CFP — 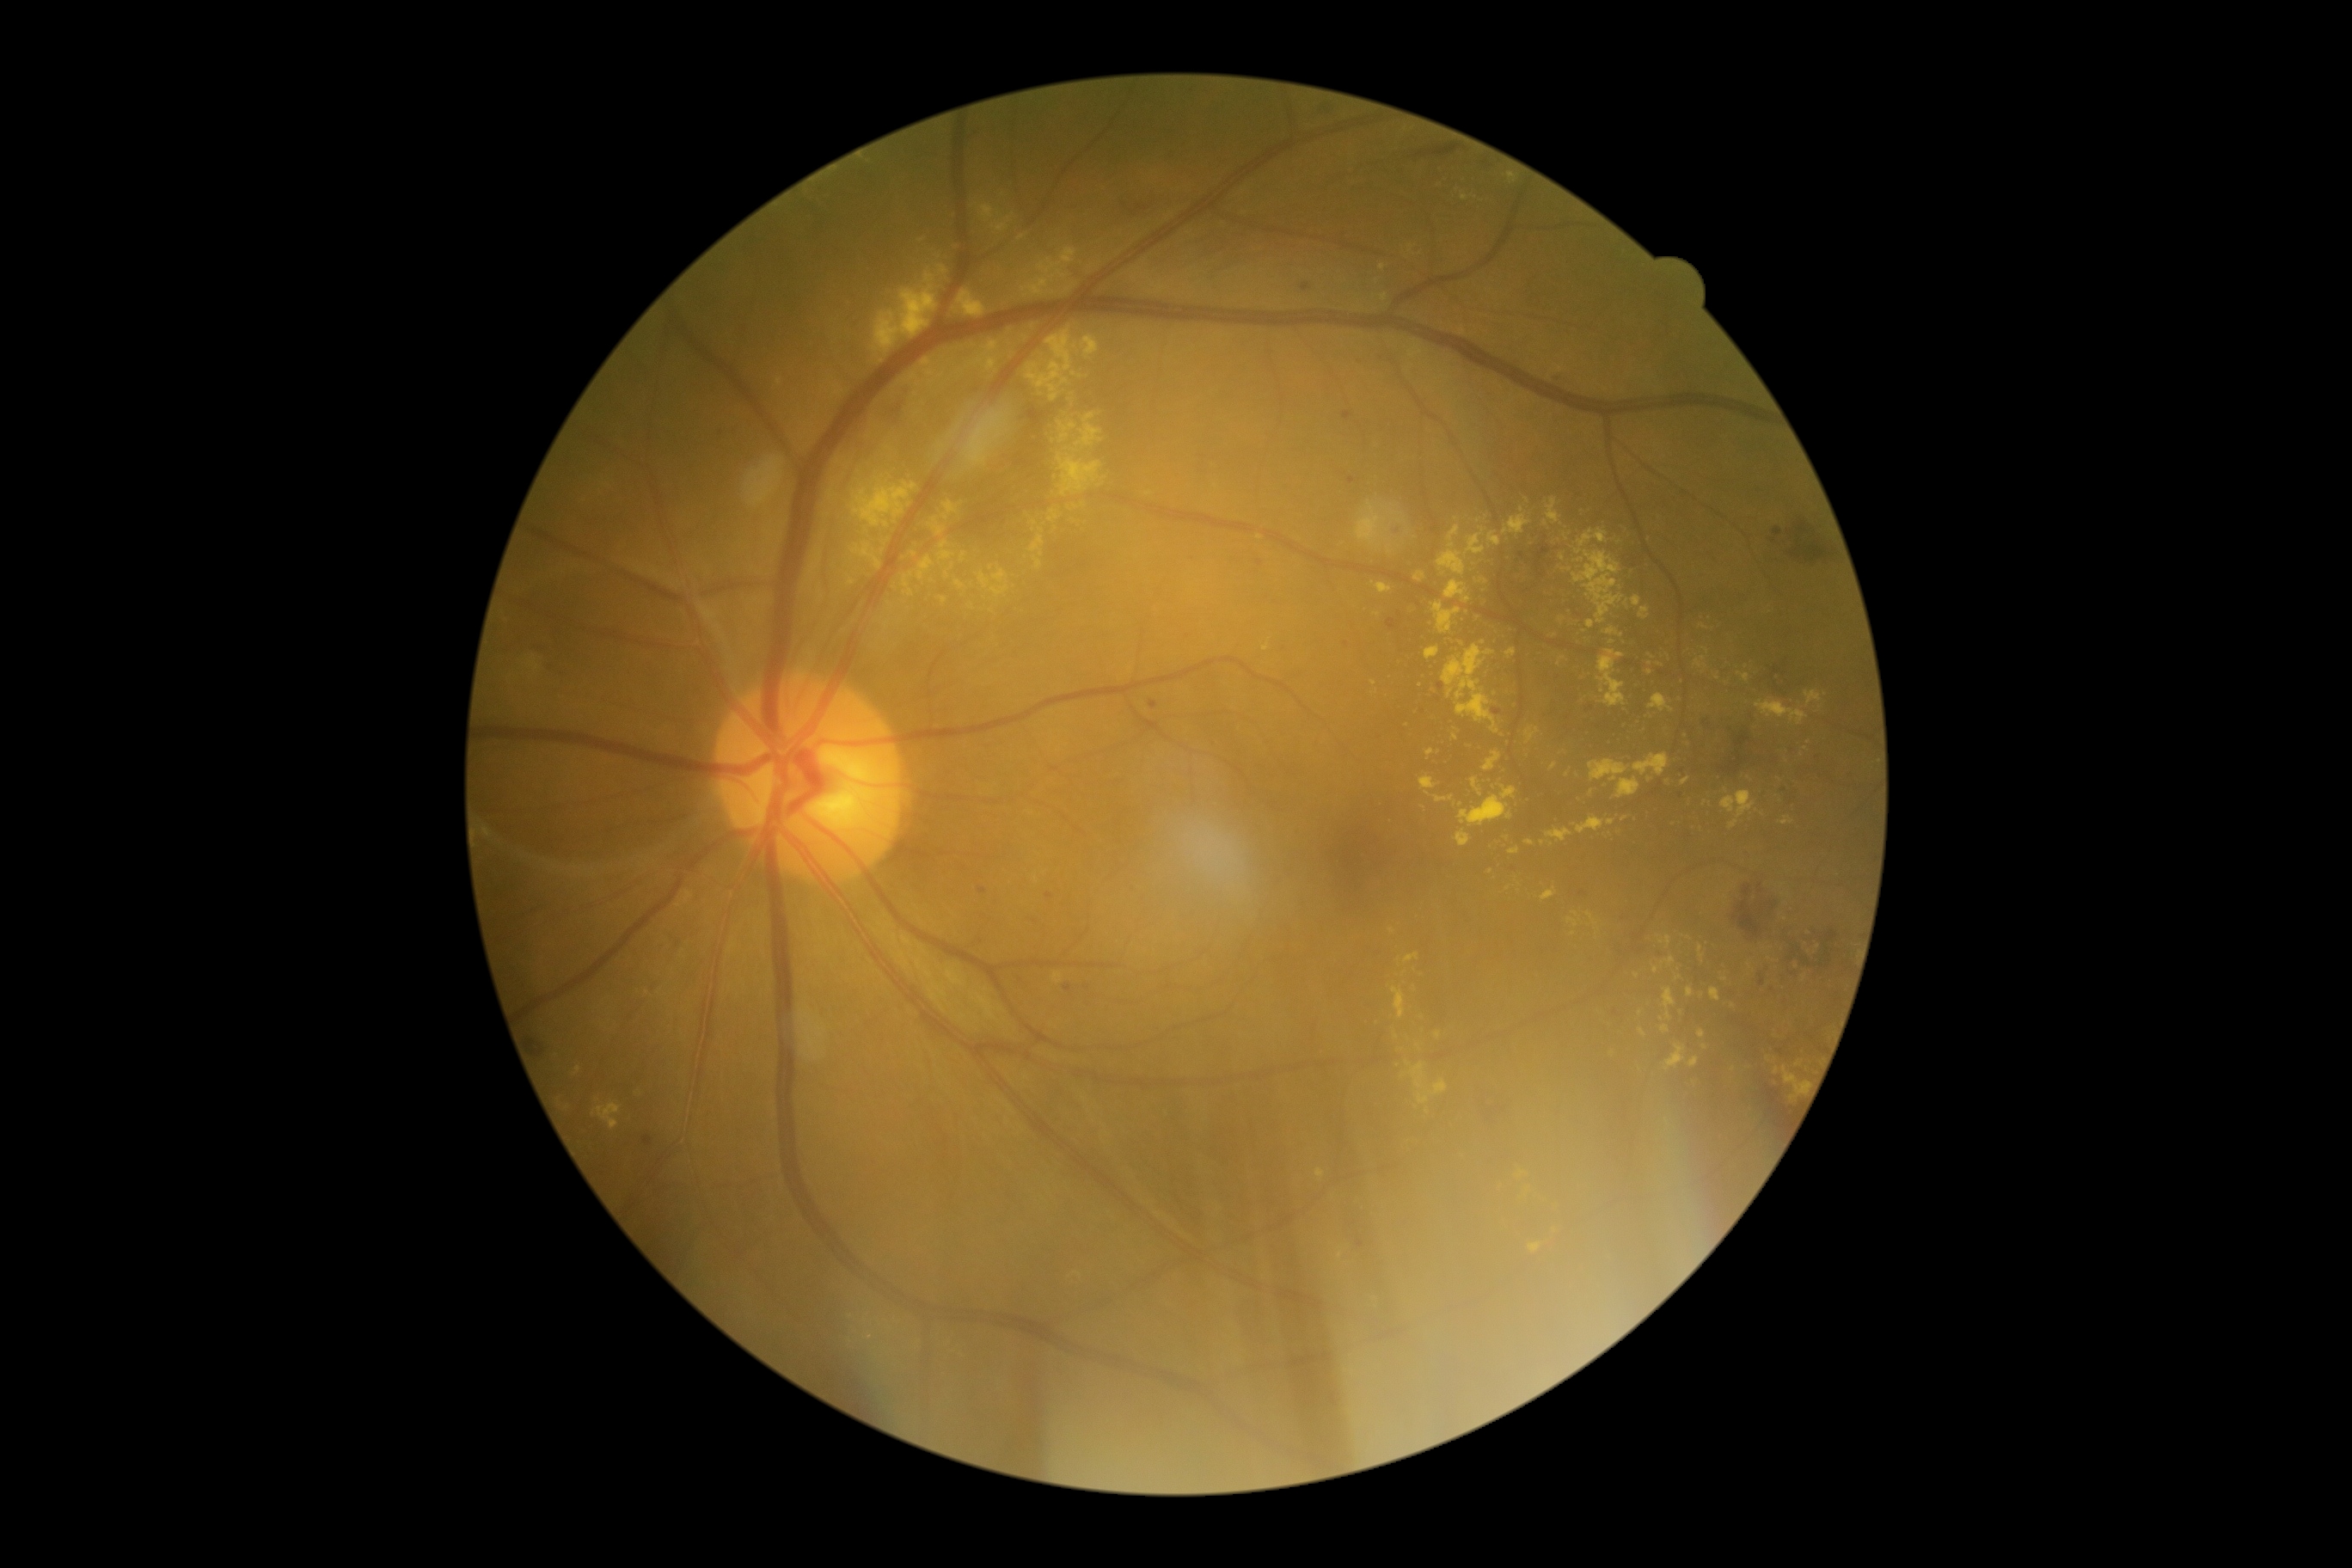 Retinopathy grade is moderate non-proliferative diabetic retinopathy (2) — more than just microaneurysms but less than severe NPDR
Representative lesions:
• hard exudates (subset): [850,542,883,570], [1067,448,1079,453], [917,558,934,580], [1509,848,1521,855], [1402,1062,1449,1103], [1662,957,1675,967], [1149,281,1167,293], [1576,558,1584,563], [903,573,914,597], [1665,1044,1687,1070], [1780,818,1794,826]
• Smaller hard exudates around <point>1678, 977</point>, <point>1724, 979</point>, <point>1818, 946</point>, <point>1384, 298</point>, <point>1419, 1047</point>, <point>1225, 336</point>, <point>1543, 843</point>, <point>1428, 794</point>, <point>1651, 656</point>